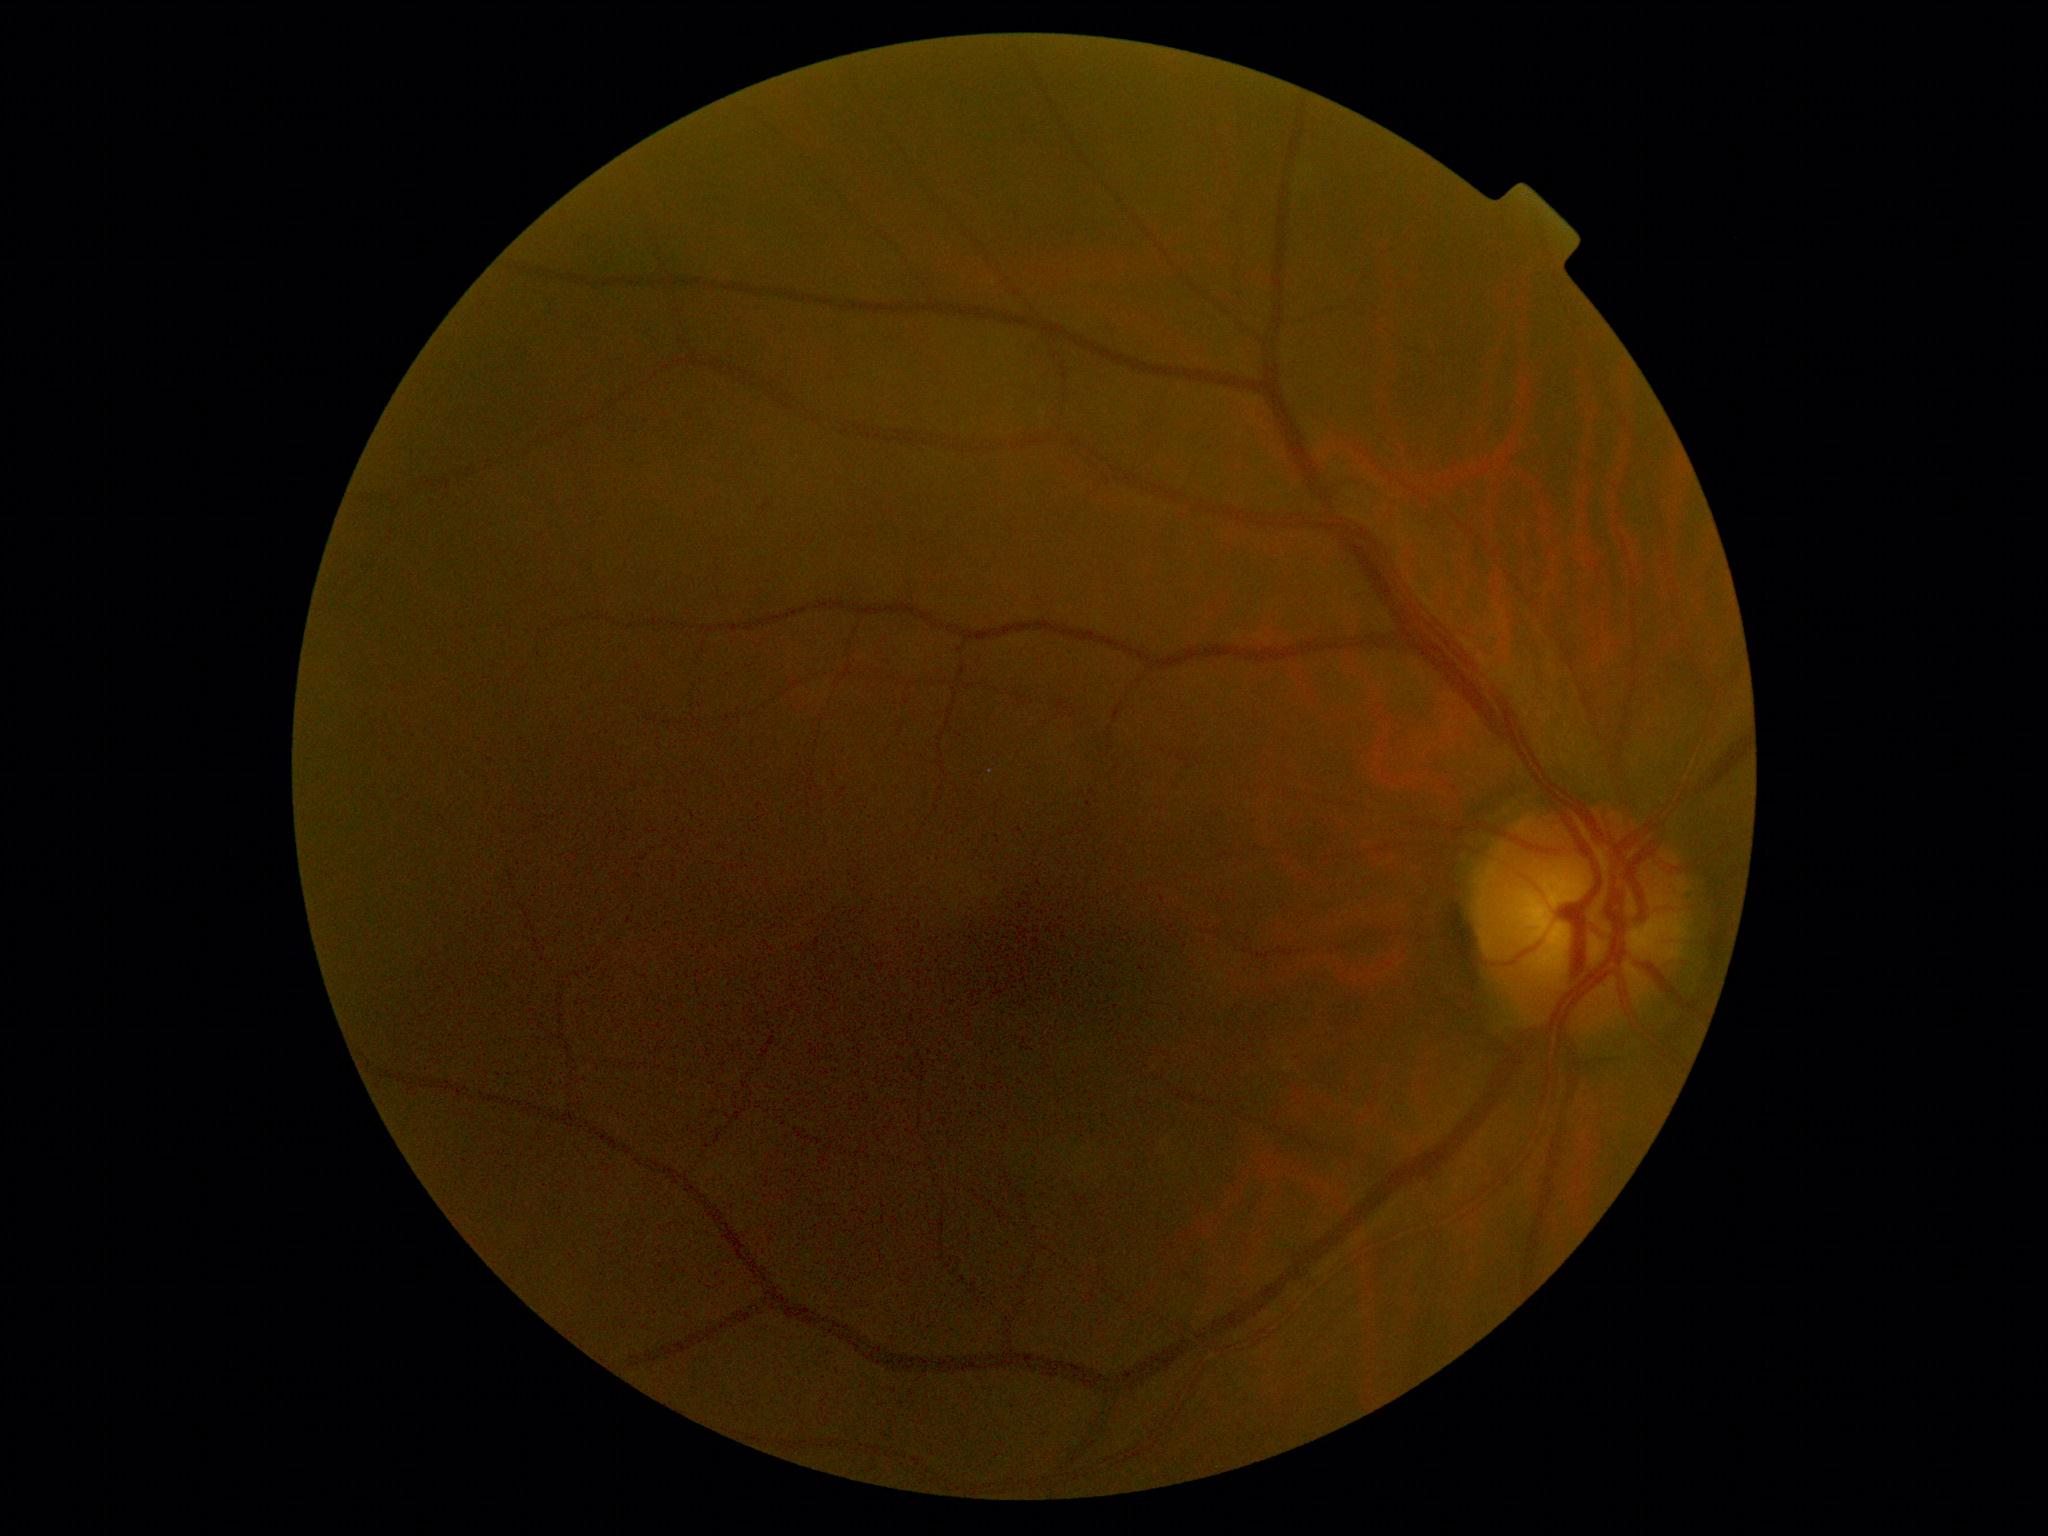
No DR findings. DR grade: 0 (no apparent retinopathy).